Wide-field contact fundus photograph of an infant. 130° field of view (Clarity RetCam 3). 640x480
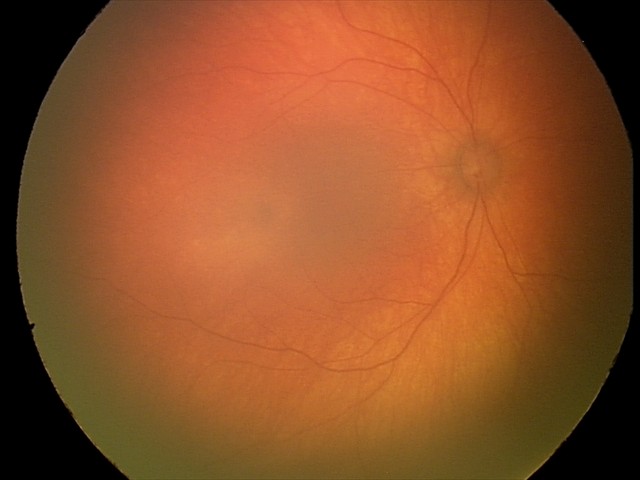

Impression: physiological.